CFP:
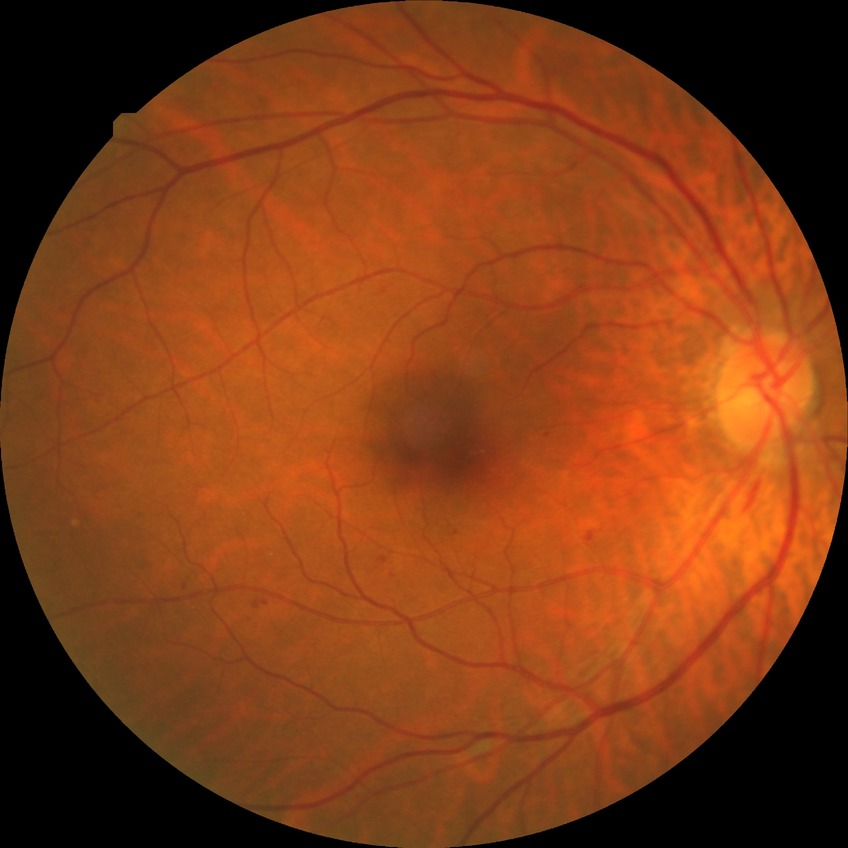
Retinopathy stage: simple diabetic retinopathy.